45° field of view, image size 2346x1568, CFP
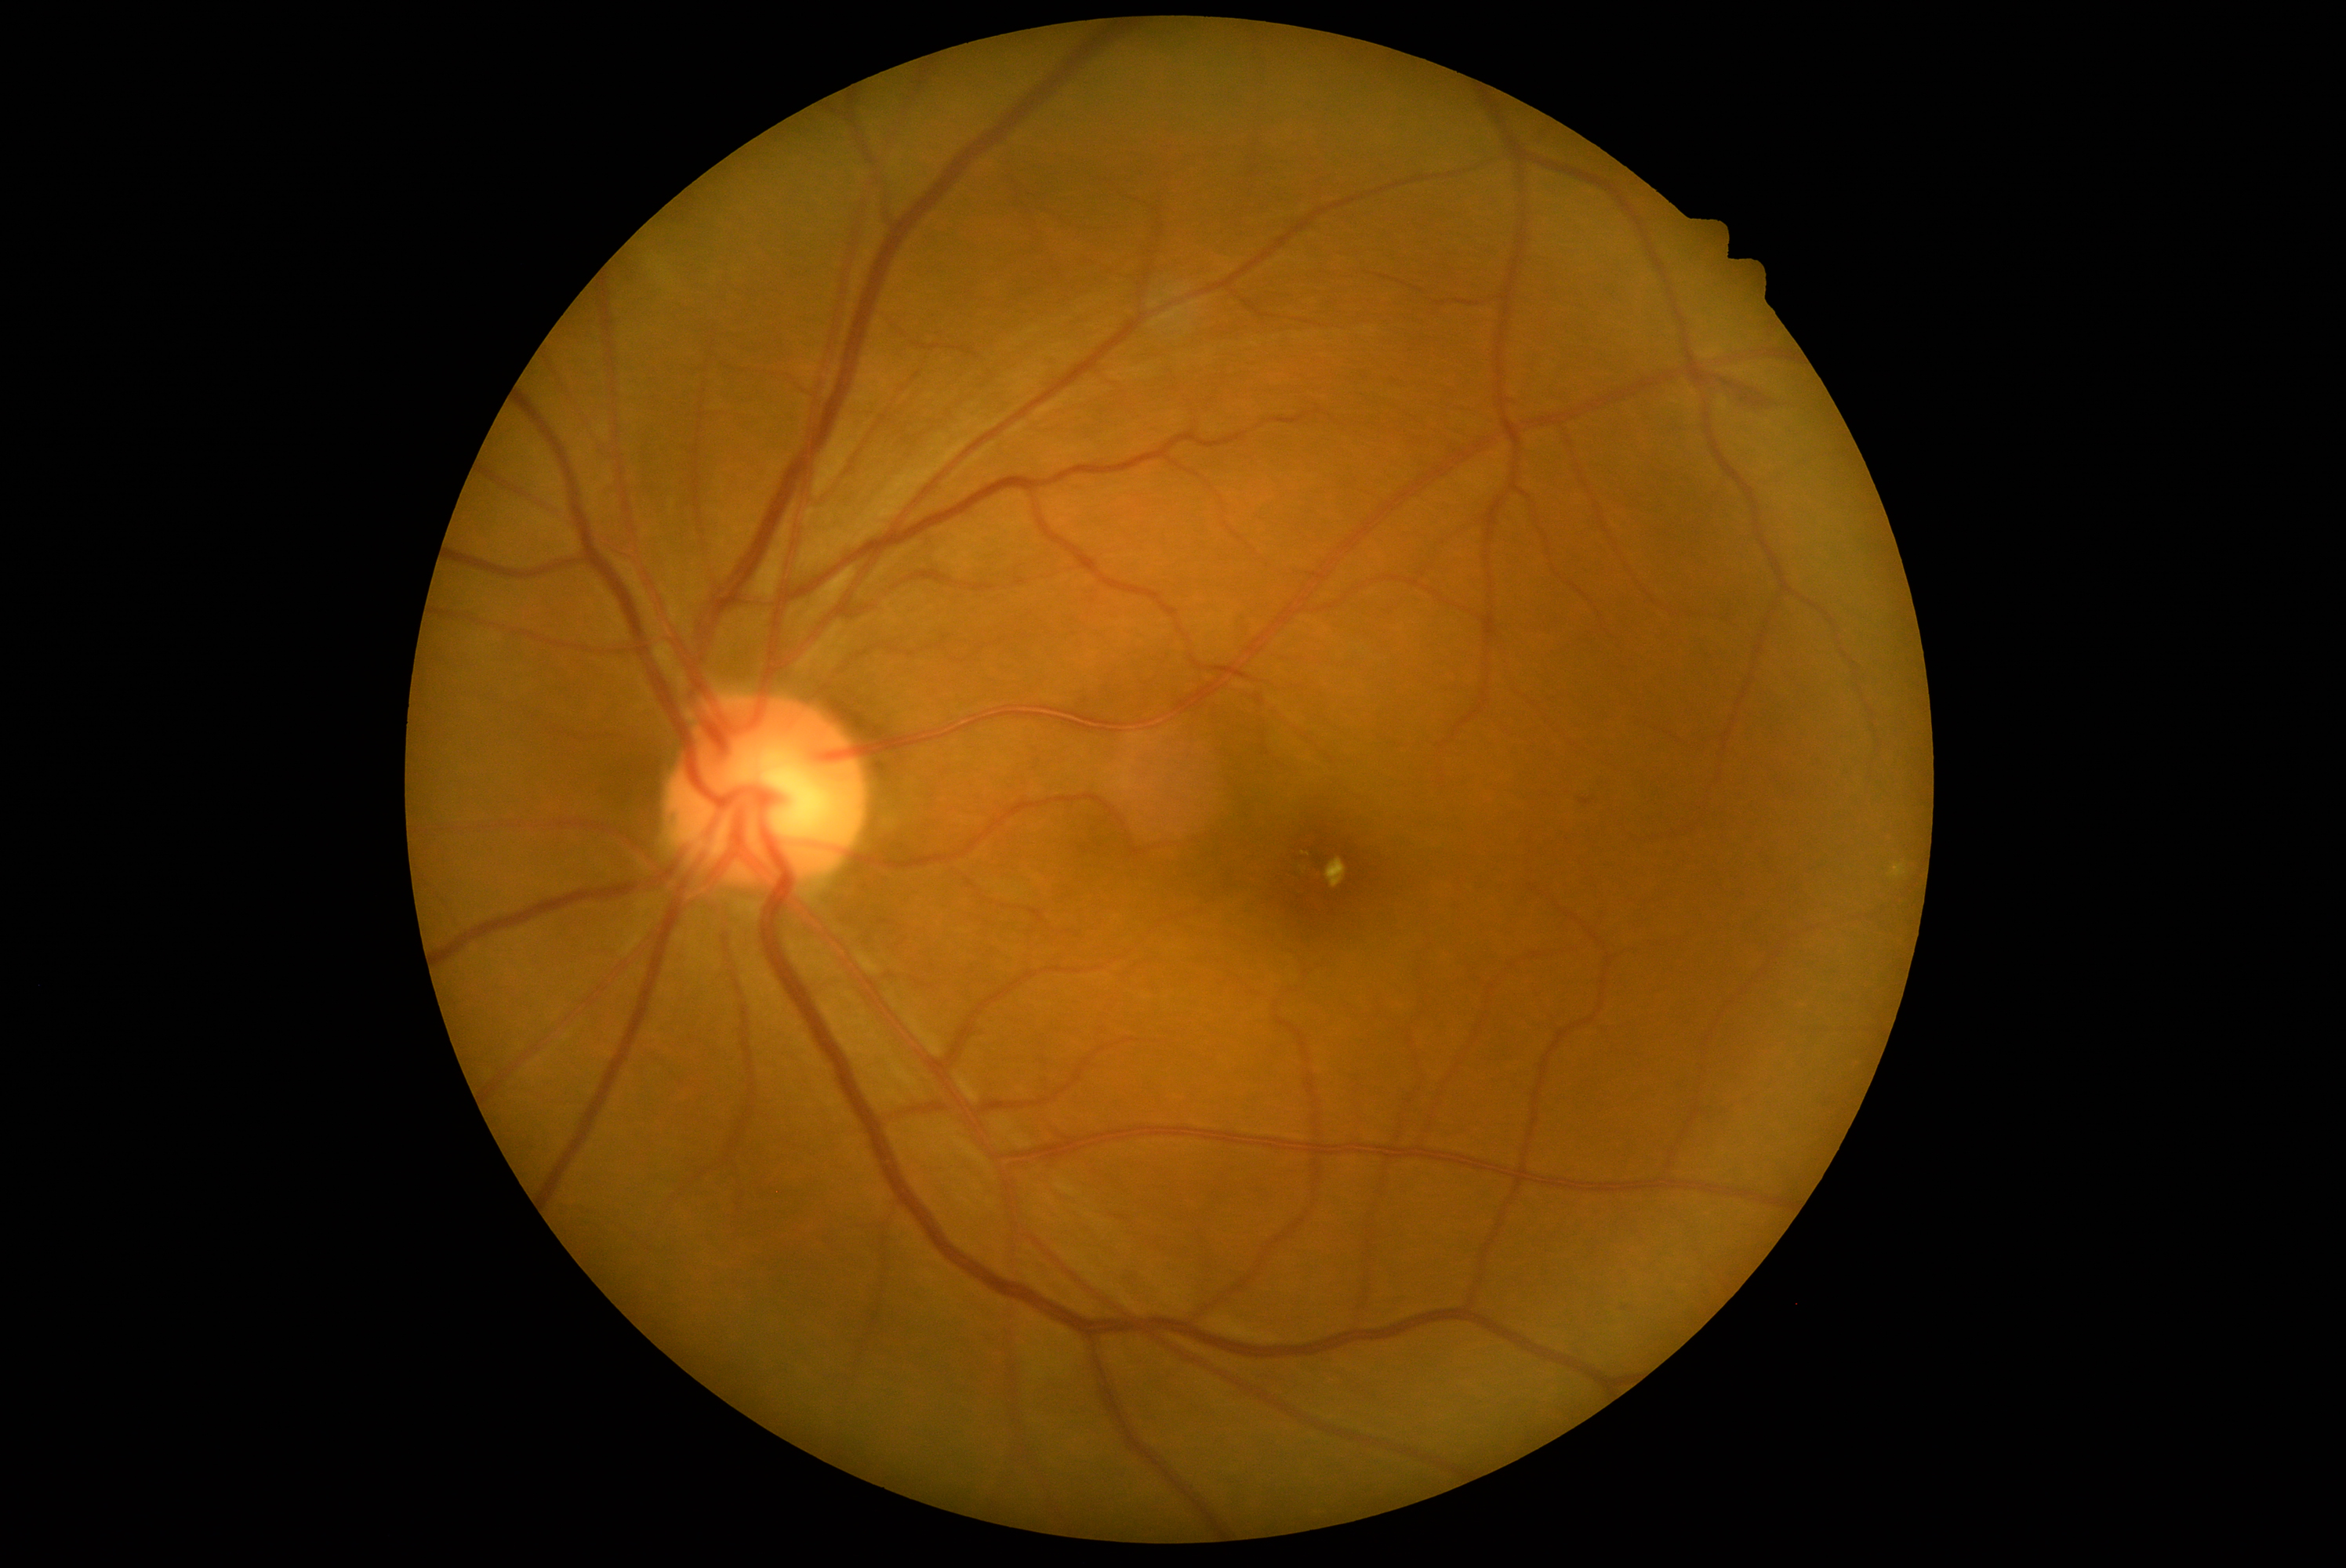
Diabetic retinopathy (DR): grade 2.